2228x1652: 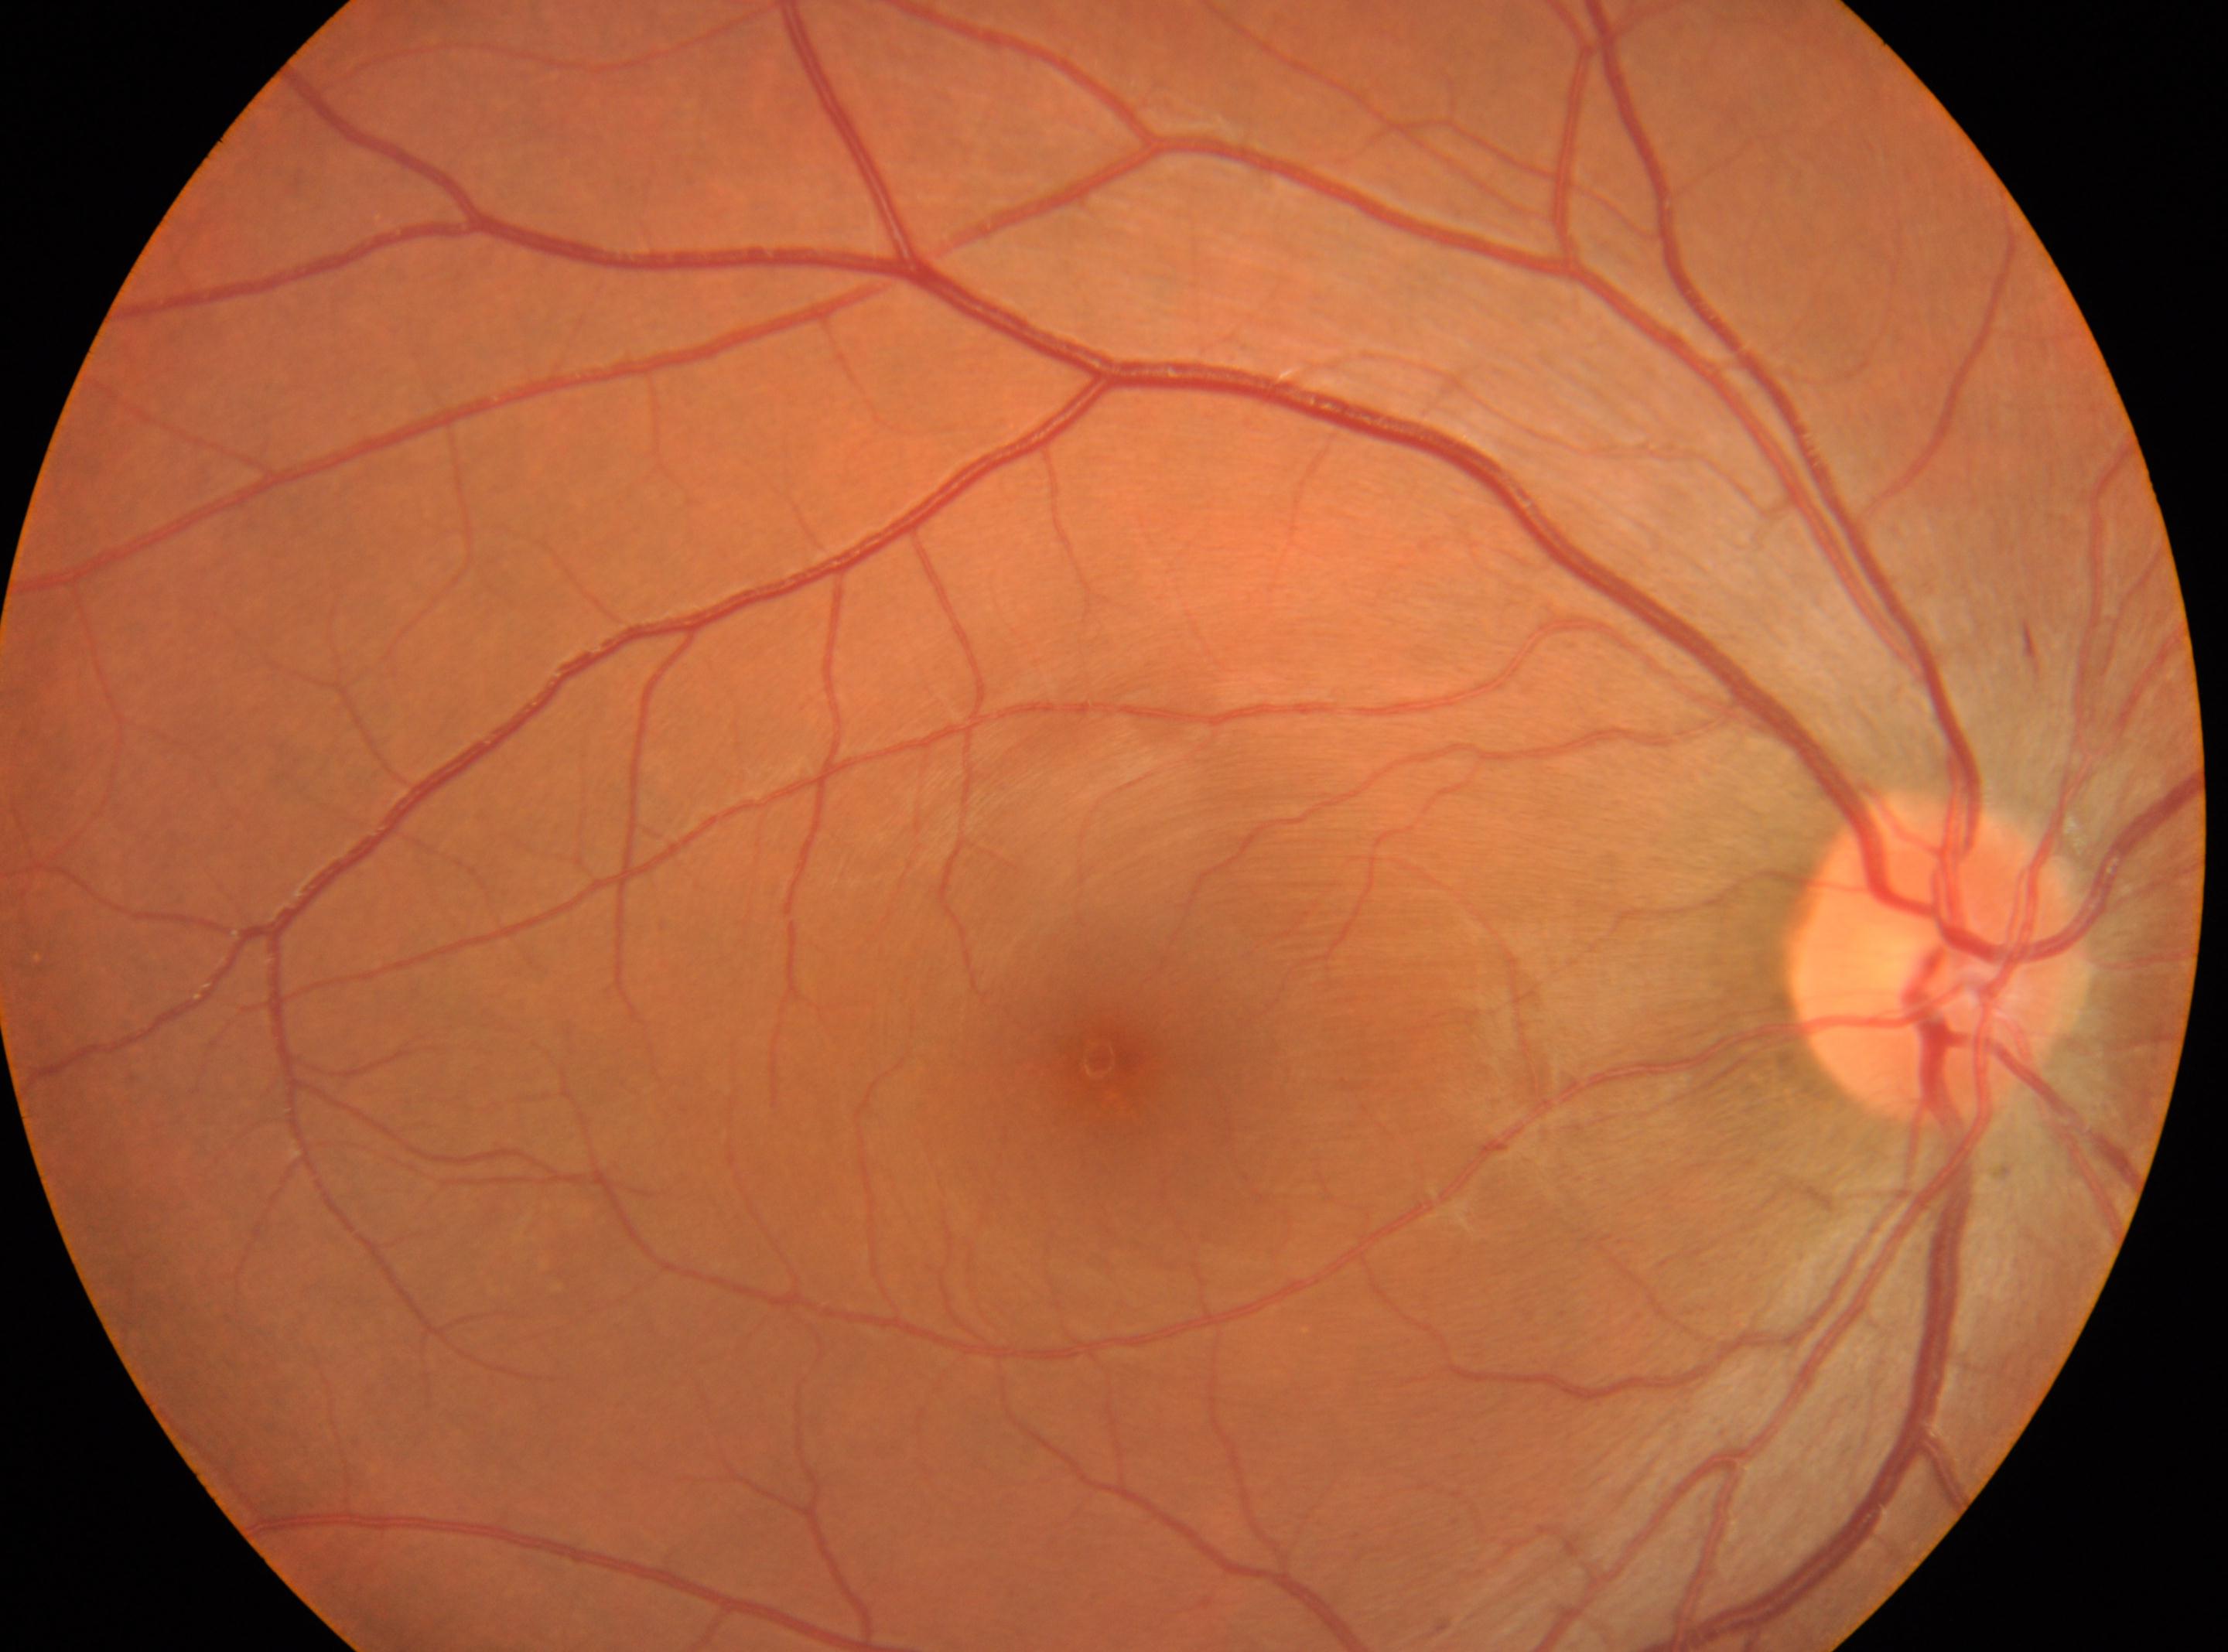
Eye: the right eye. DR is grade 0 (no apparent retinopathy). No signs of diabetic retinopathy. Optic disk located at x=1943, y=957. Fovea: x=1106, y=1061.